Phoenix ICON wide-field infant fundus image: 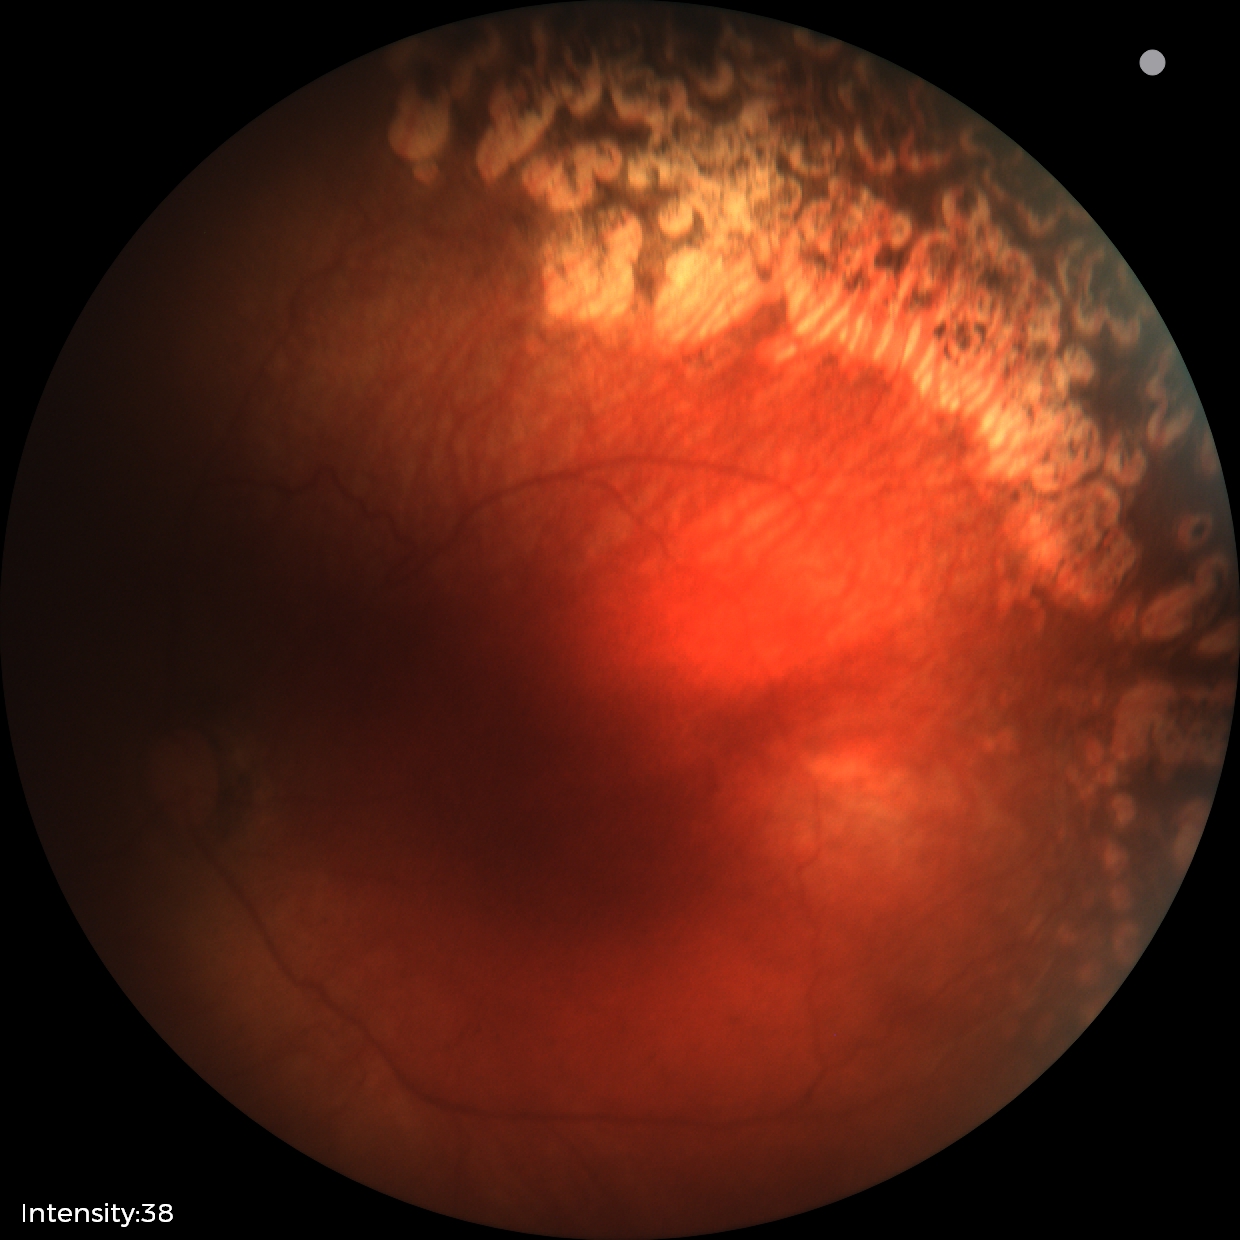

Q: What is the screening diagnosis?
A: status post retinopathy of prematurity
Q: Plus disease status?
A: no plus disease